Wide-field fundus image from infant ROP screening:
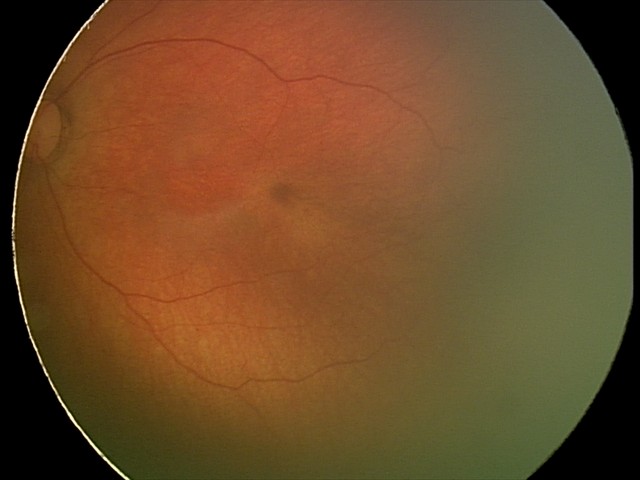
Finding: no pathology identified.